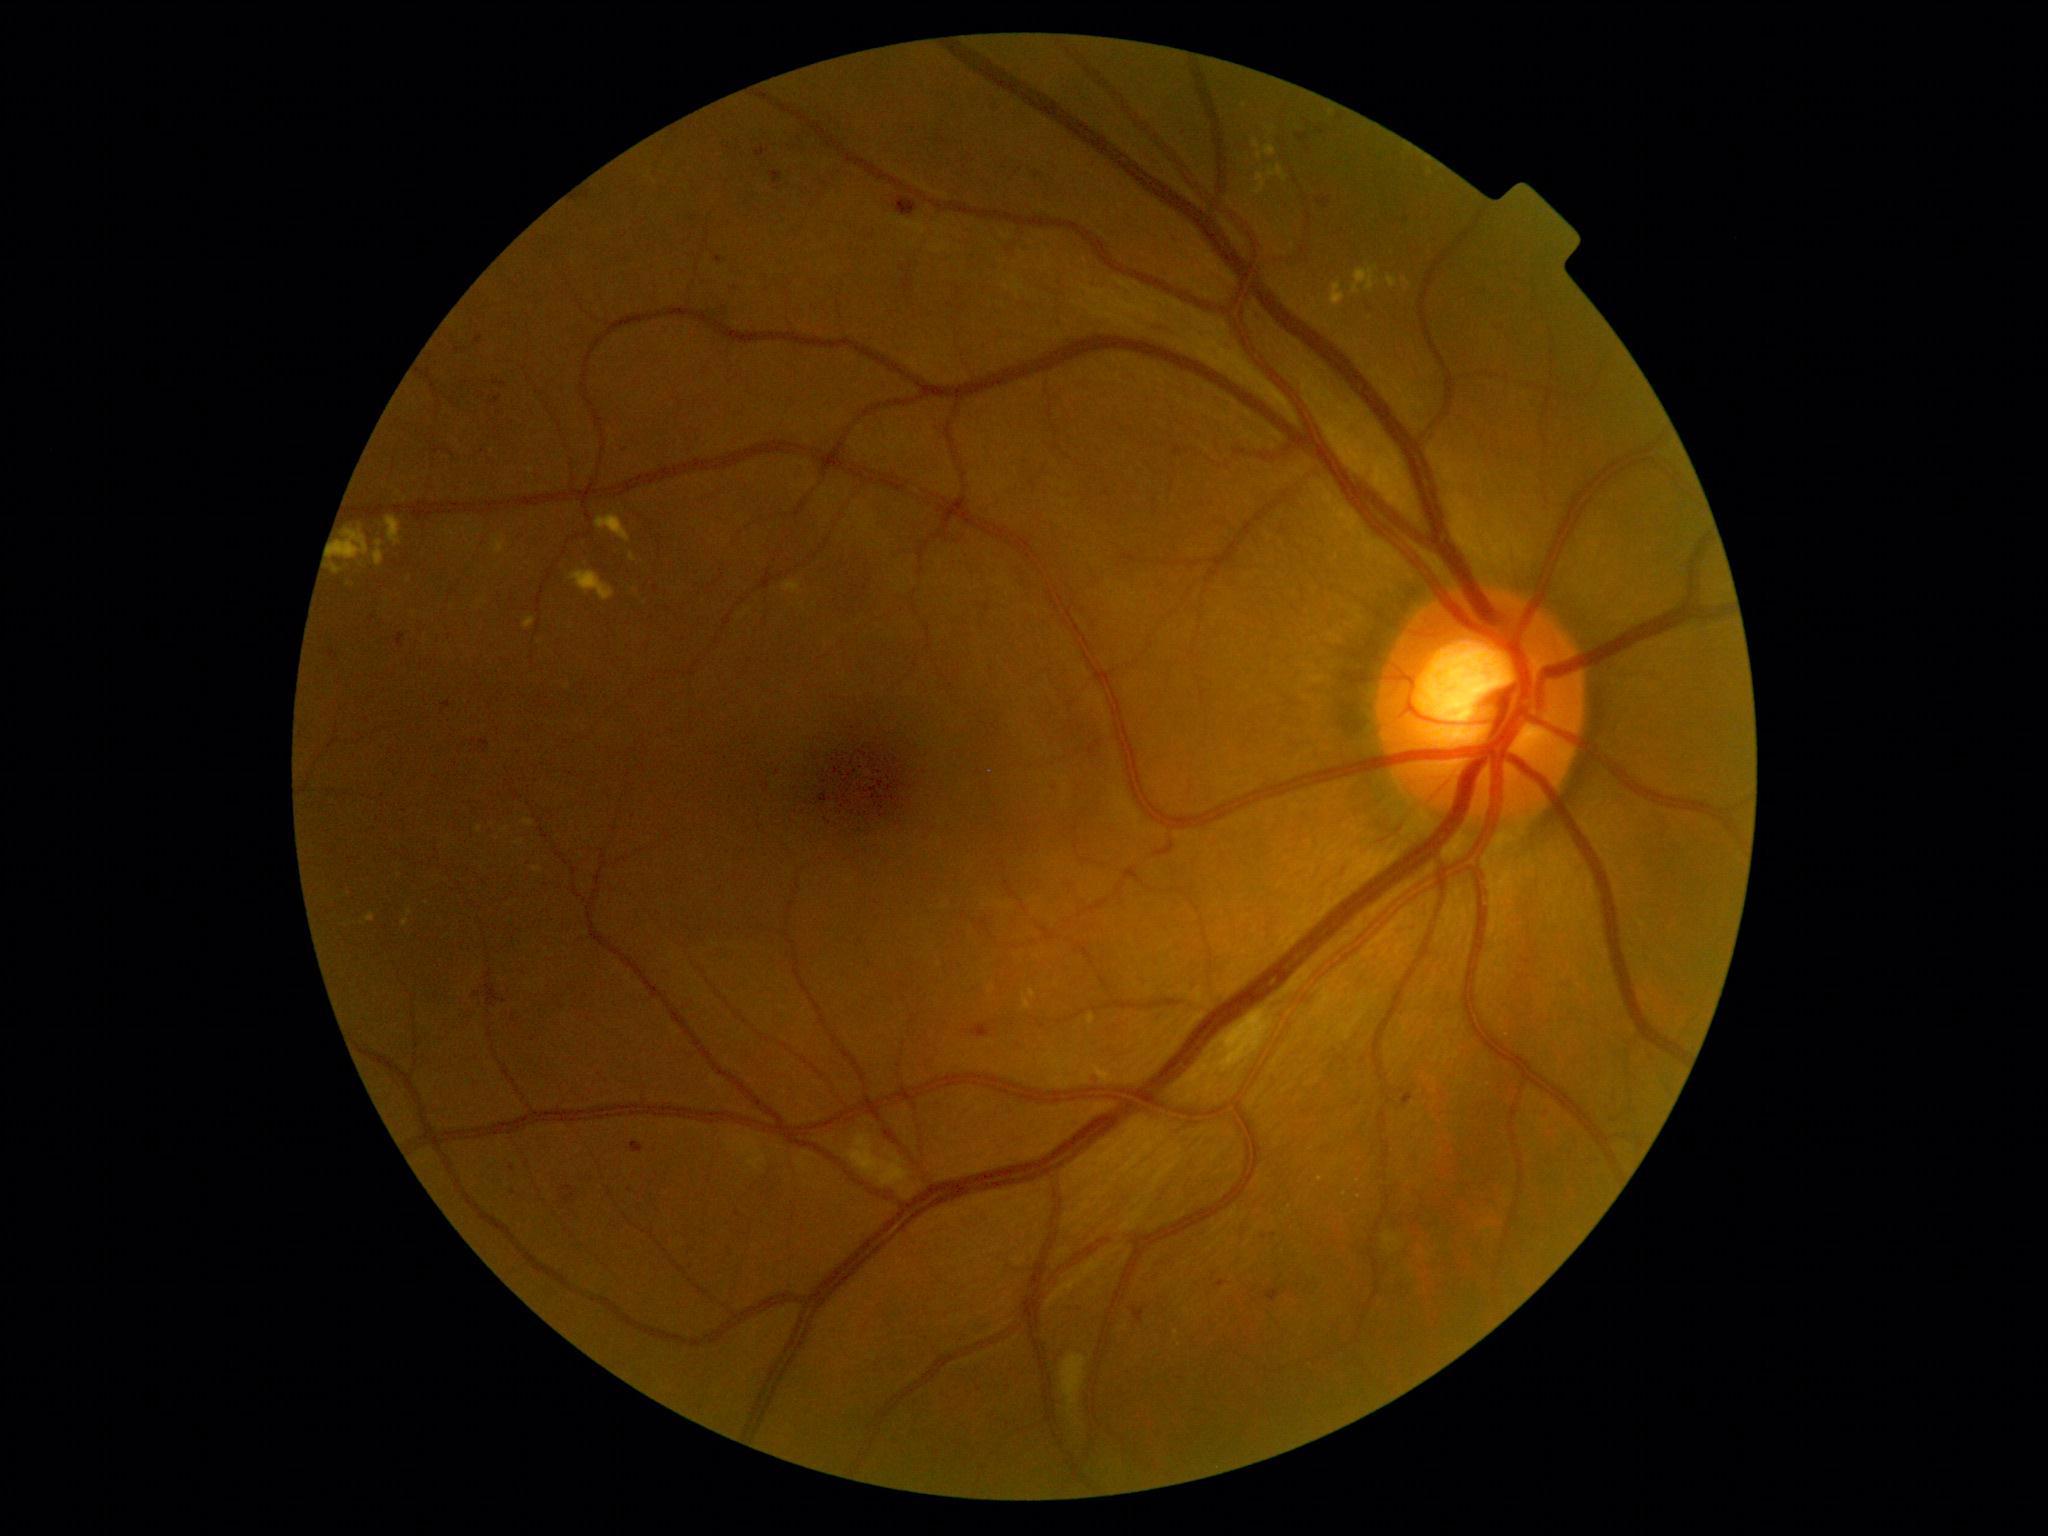 – diabetic retinopathy grade: 2 (moderate NPDR)